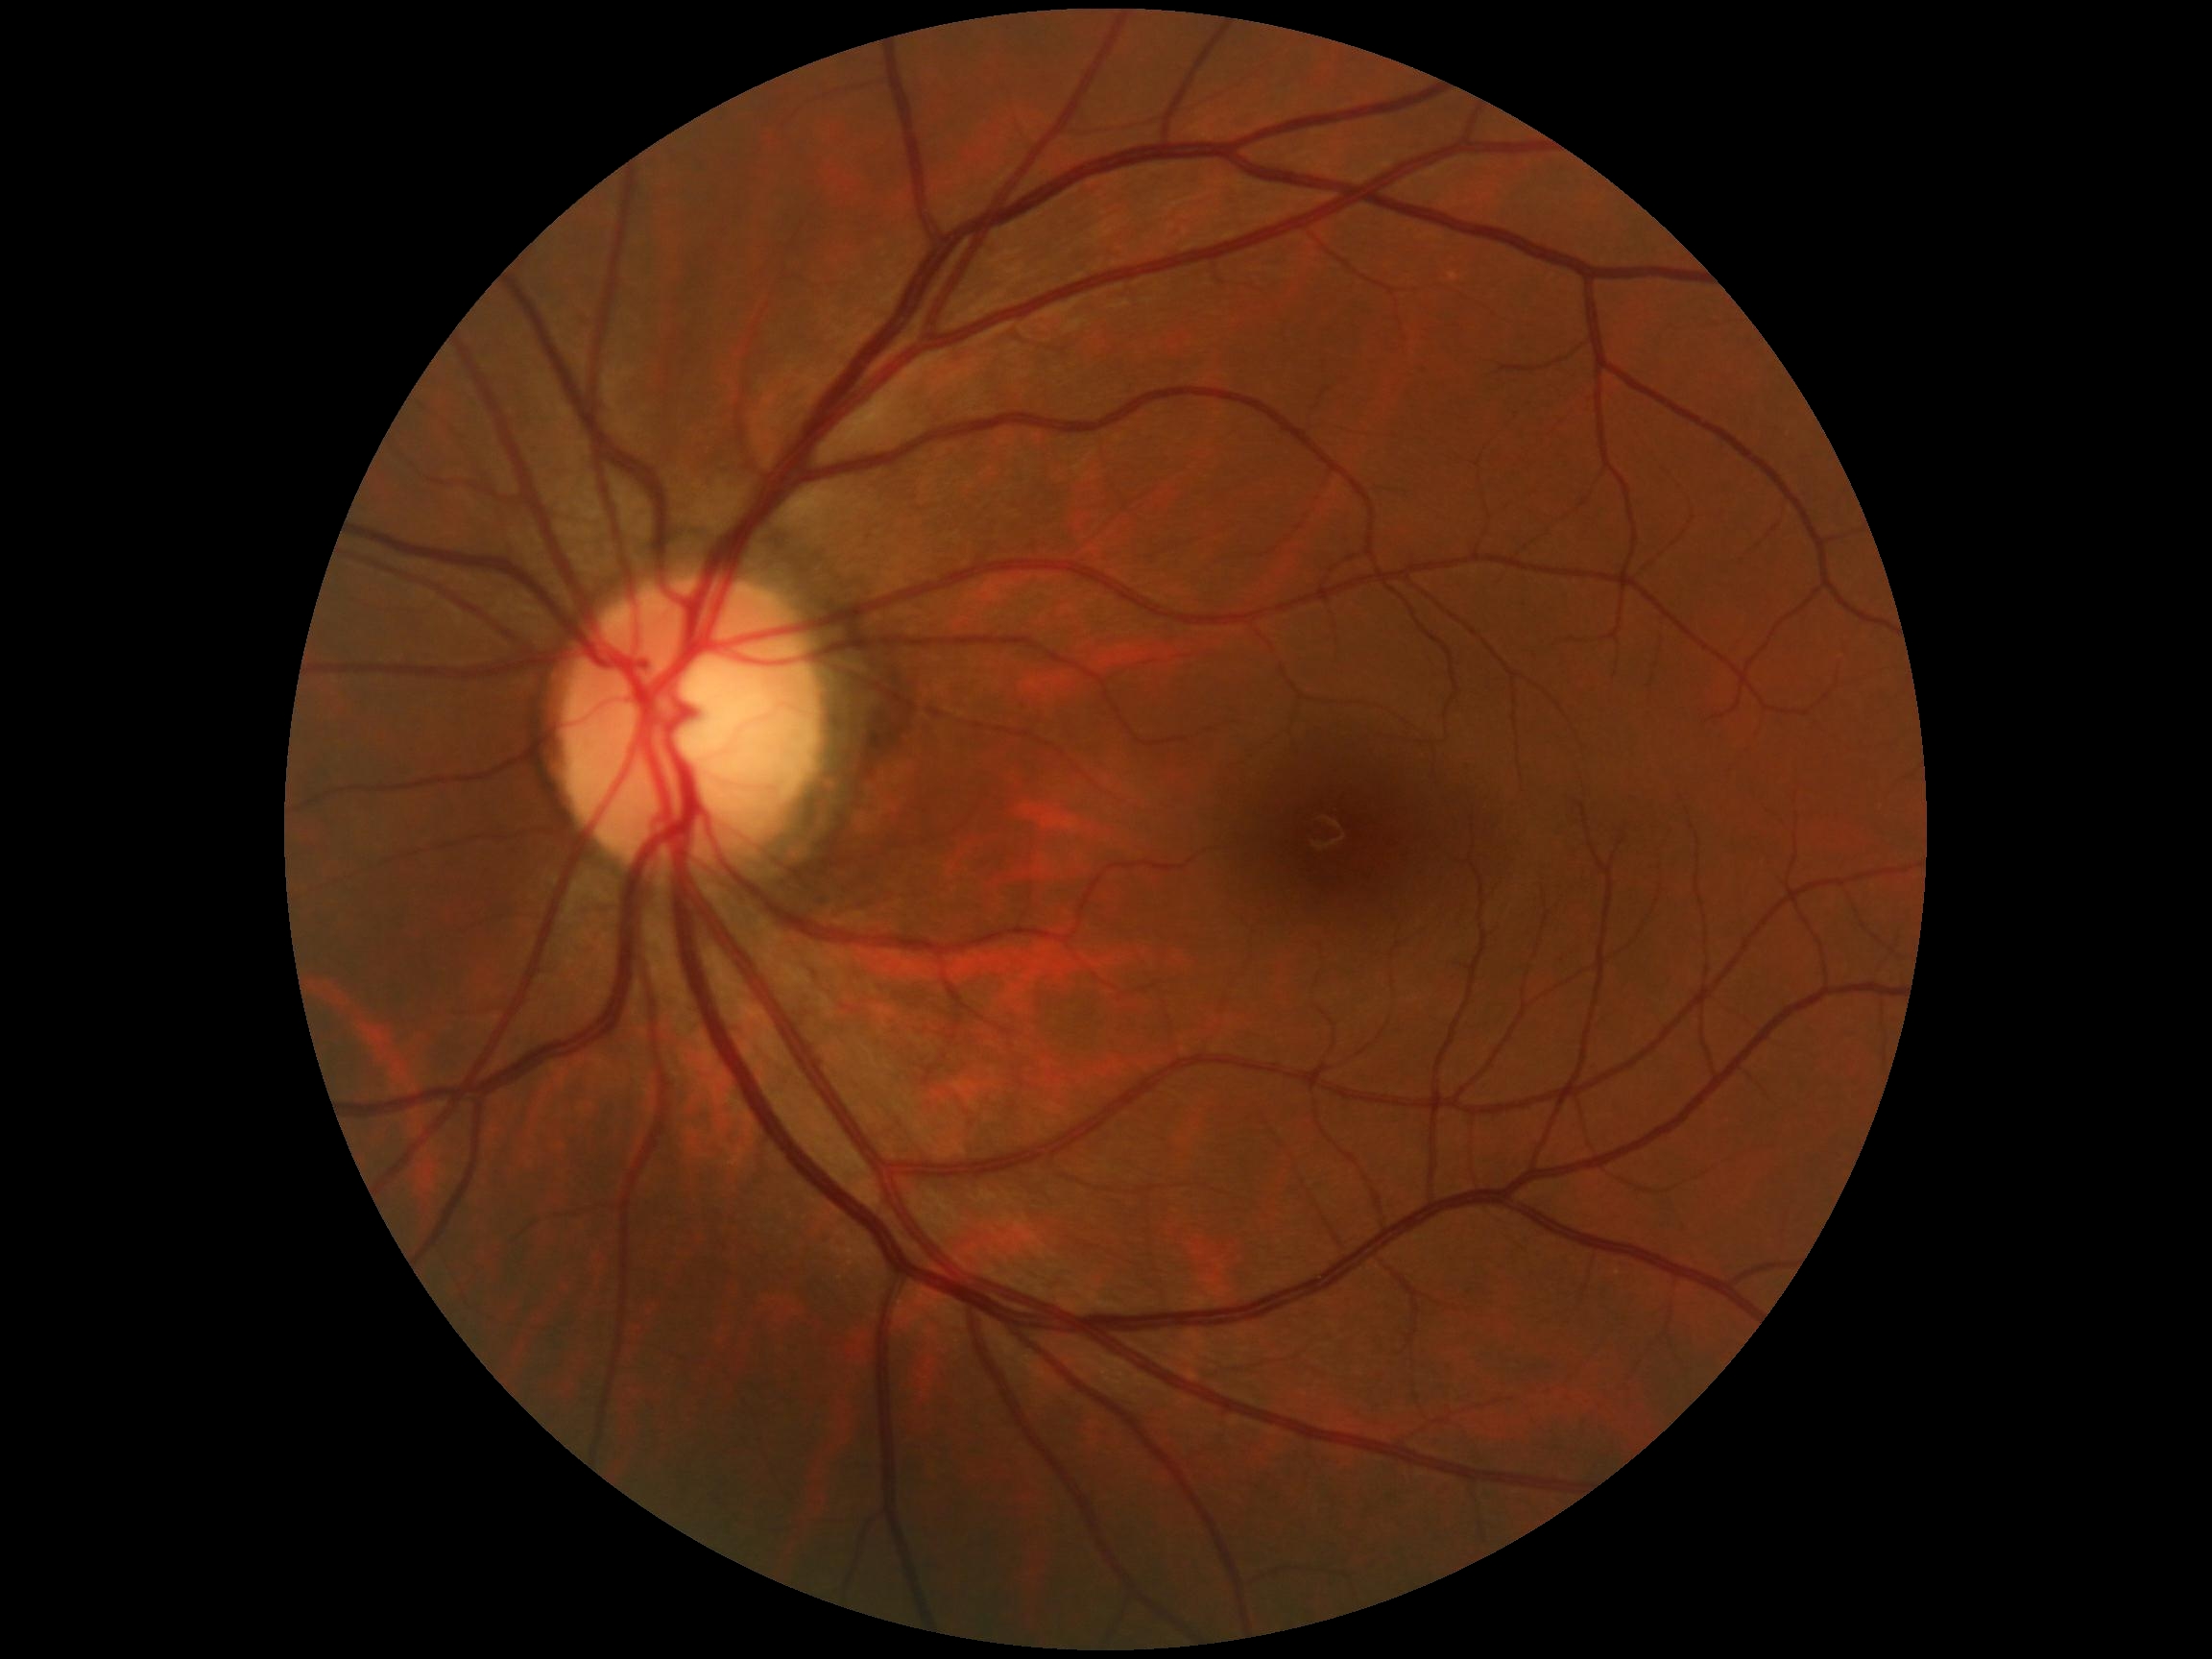 Findings:
* diabetic retinopathy — 0 — no visible signs of diabetic retinopathy
* DR impression — no signs of DR